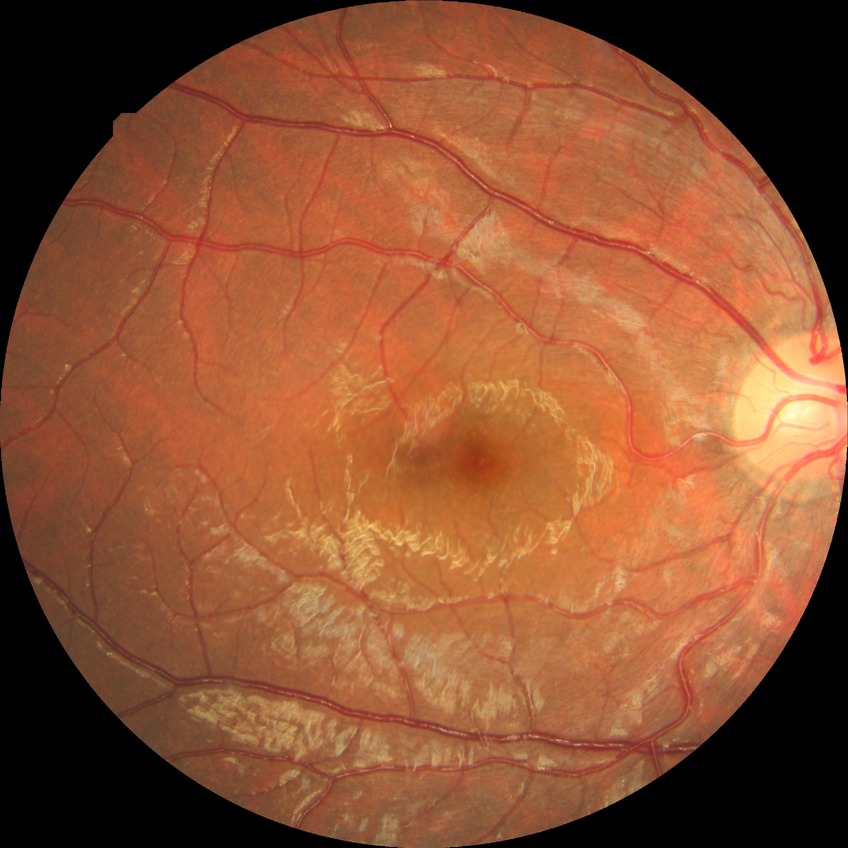

Diabetic retinopathy severity: no diabetic retinopathy.